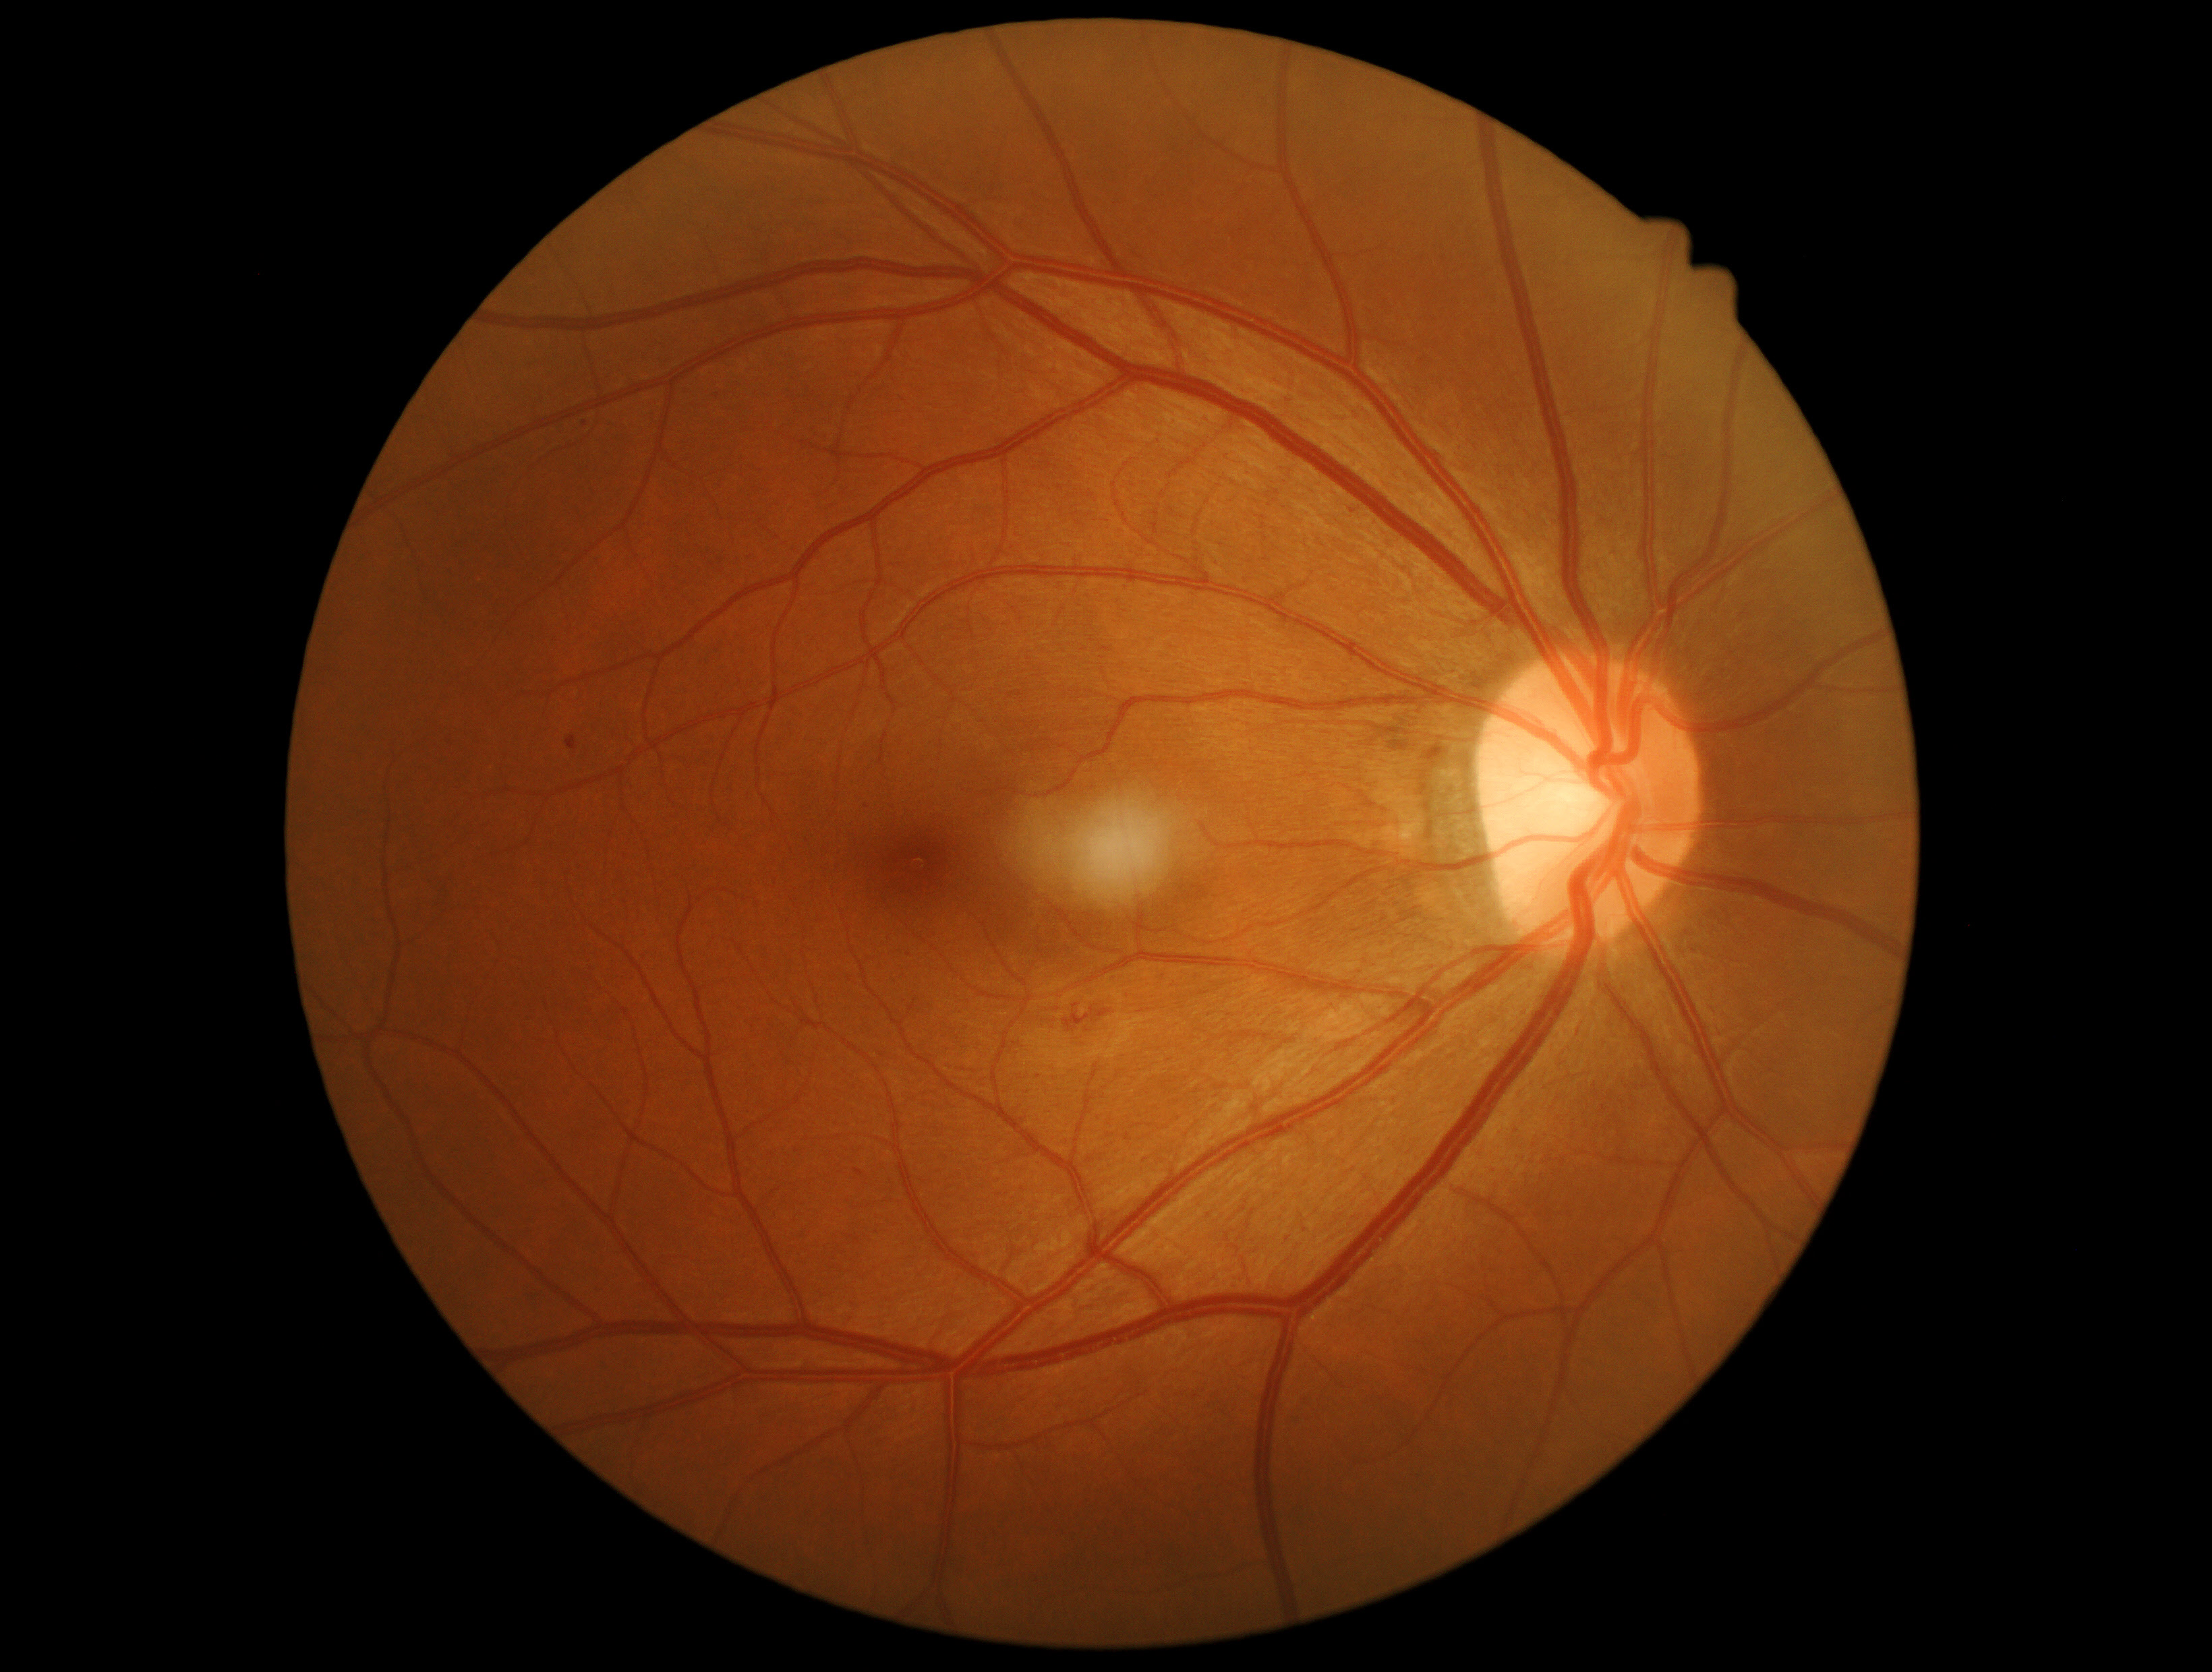 DR stage: moderate non-proliferative diabetic retinopathy (grade 2).